1725x1721px; CFP; 45-degree field of view
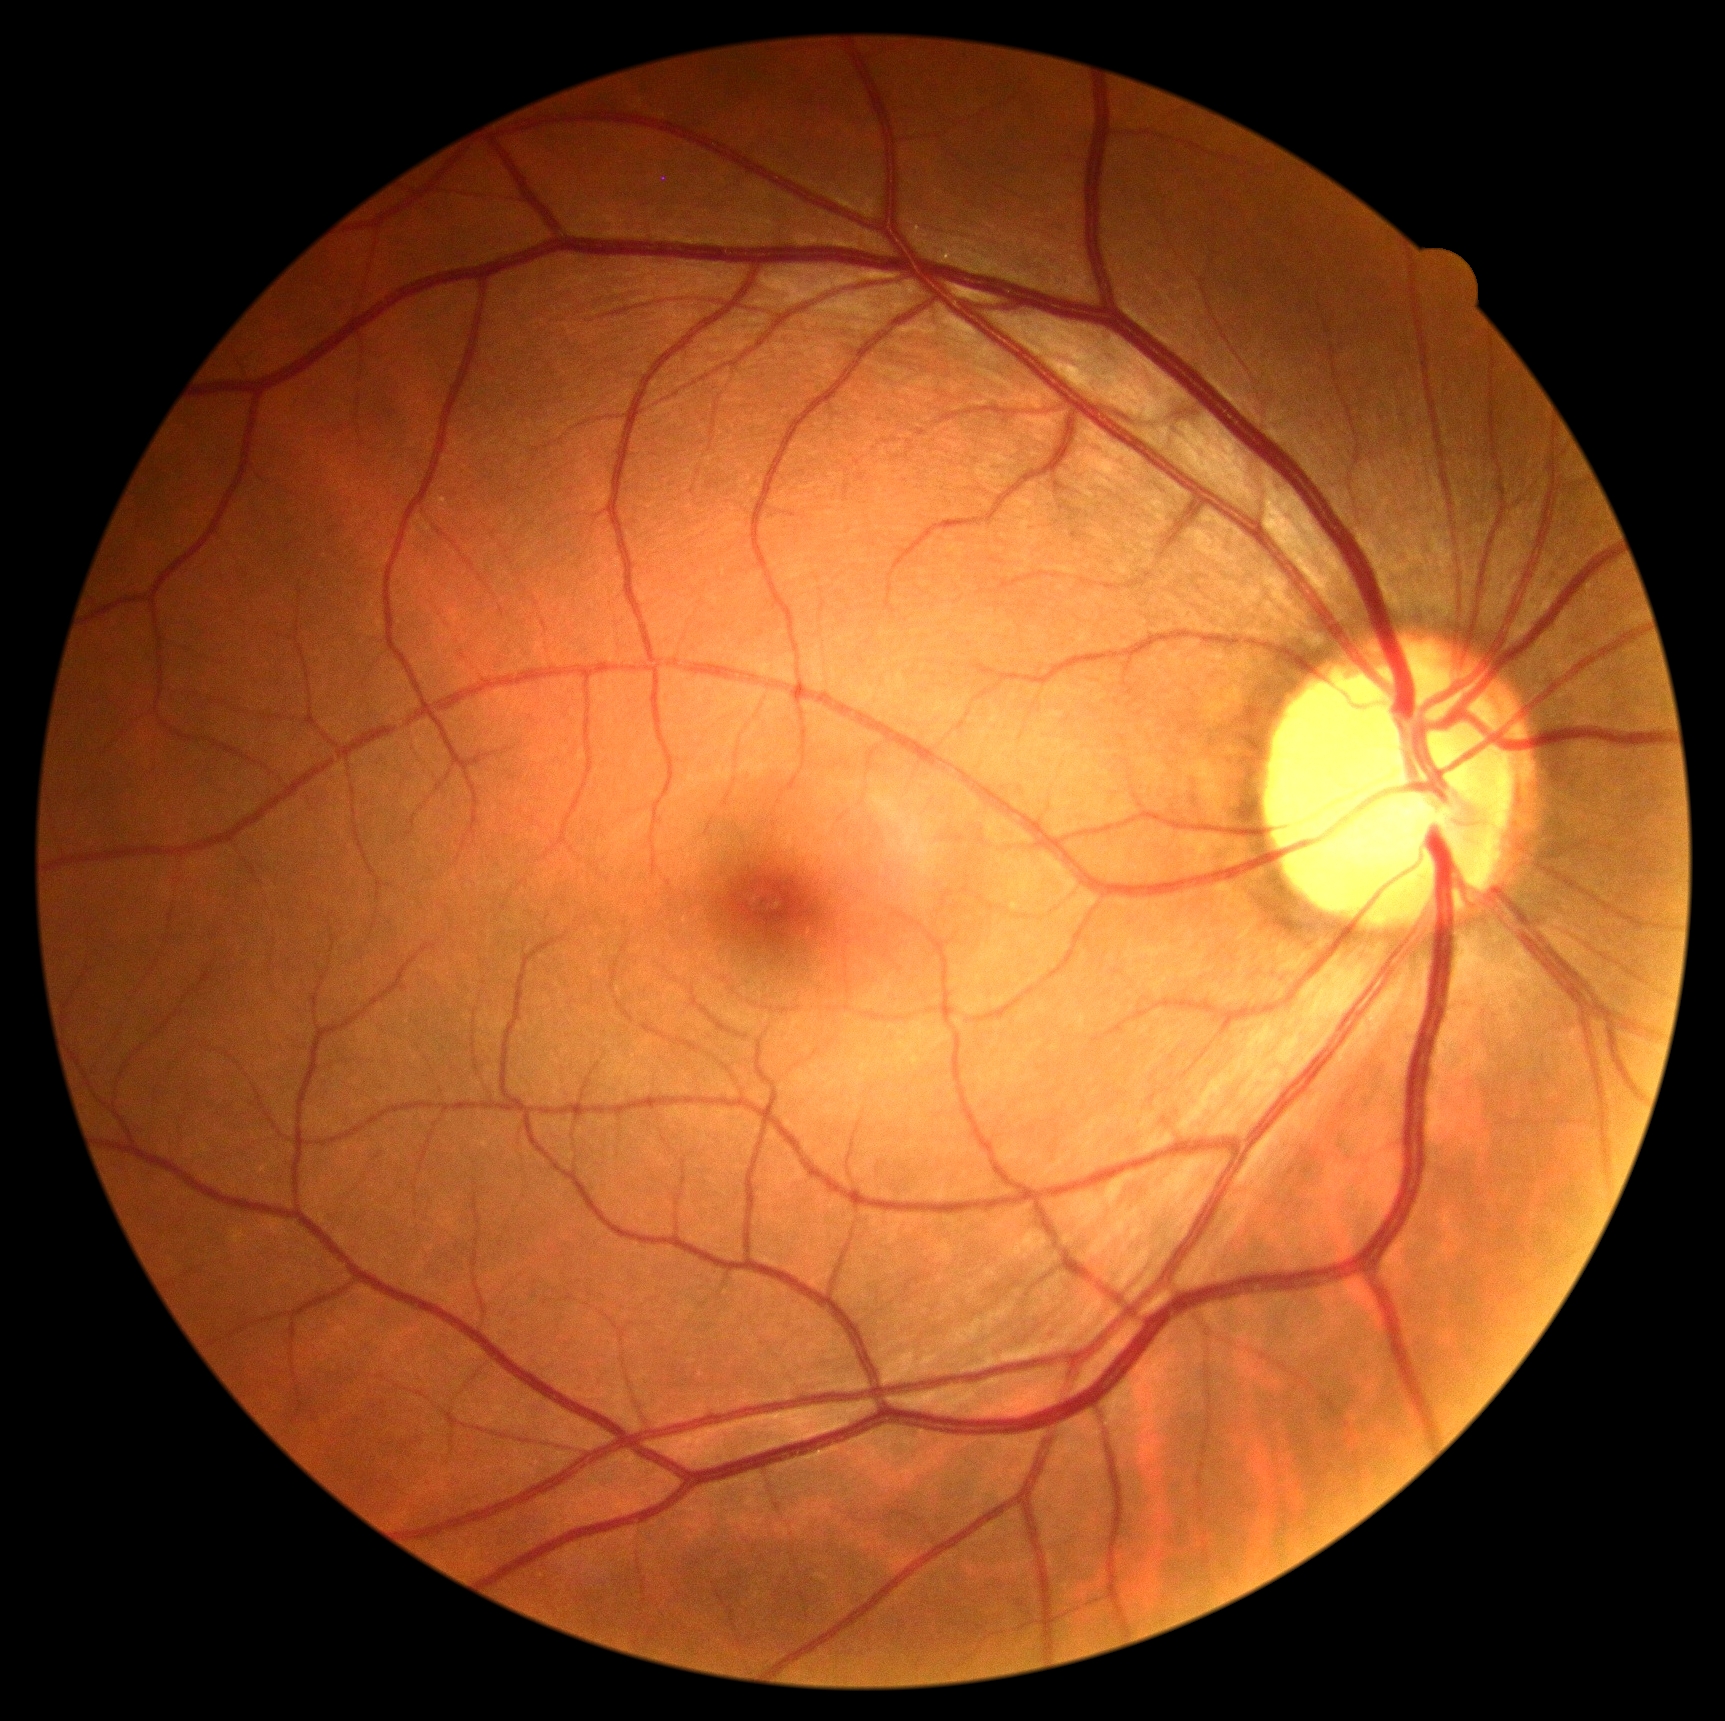

Diabetic retinopathy grade is 0.